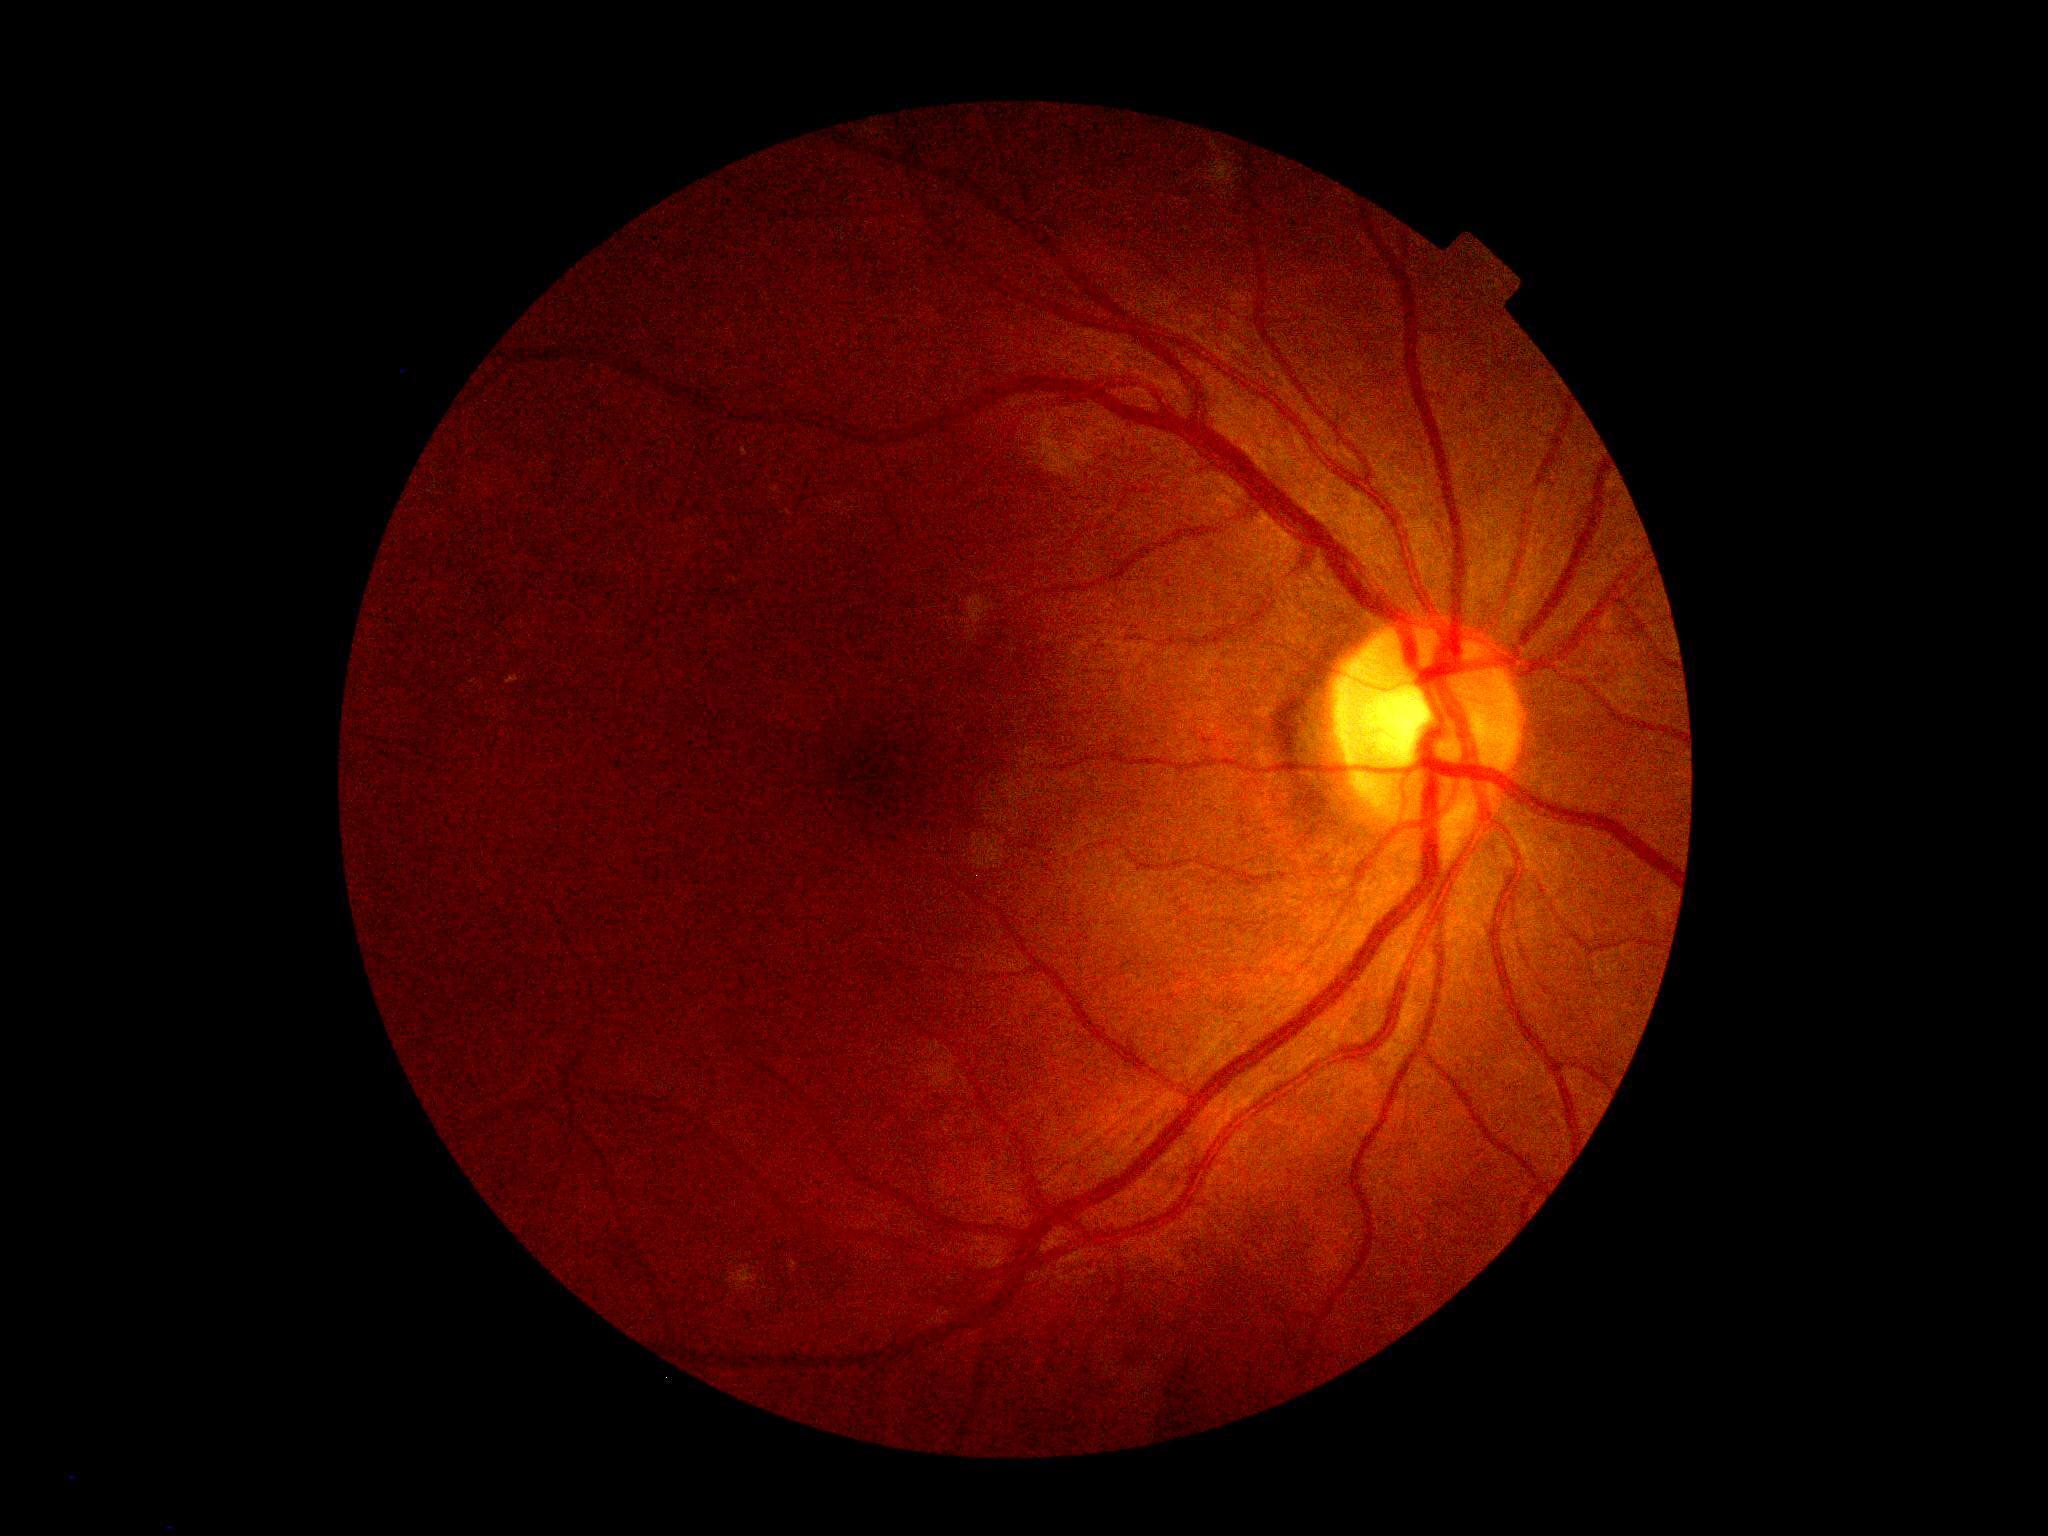
DR severity is grade 0 (no apparent retinopathy).